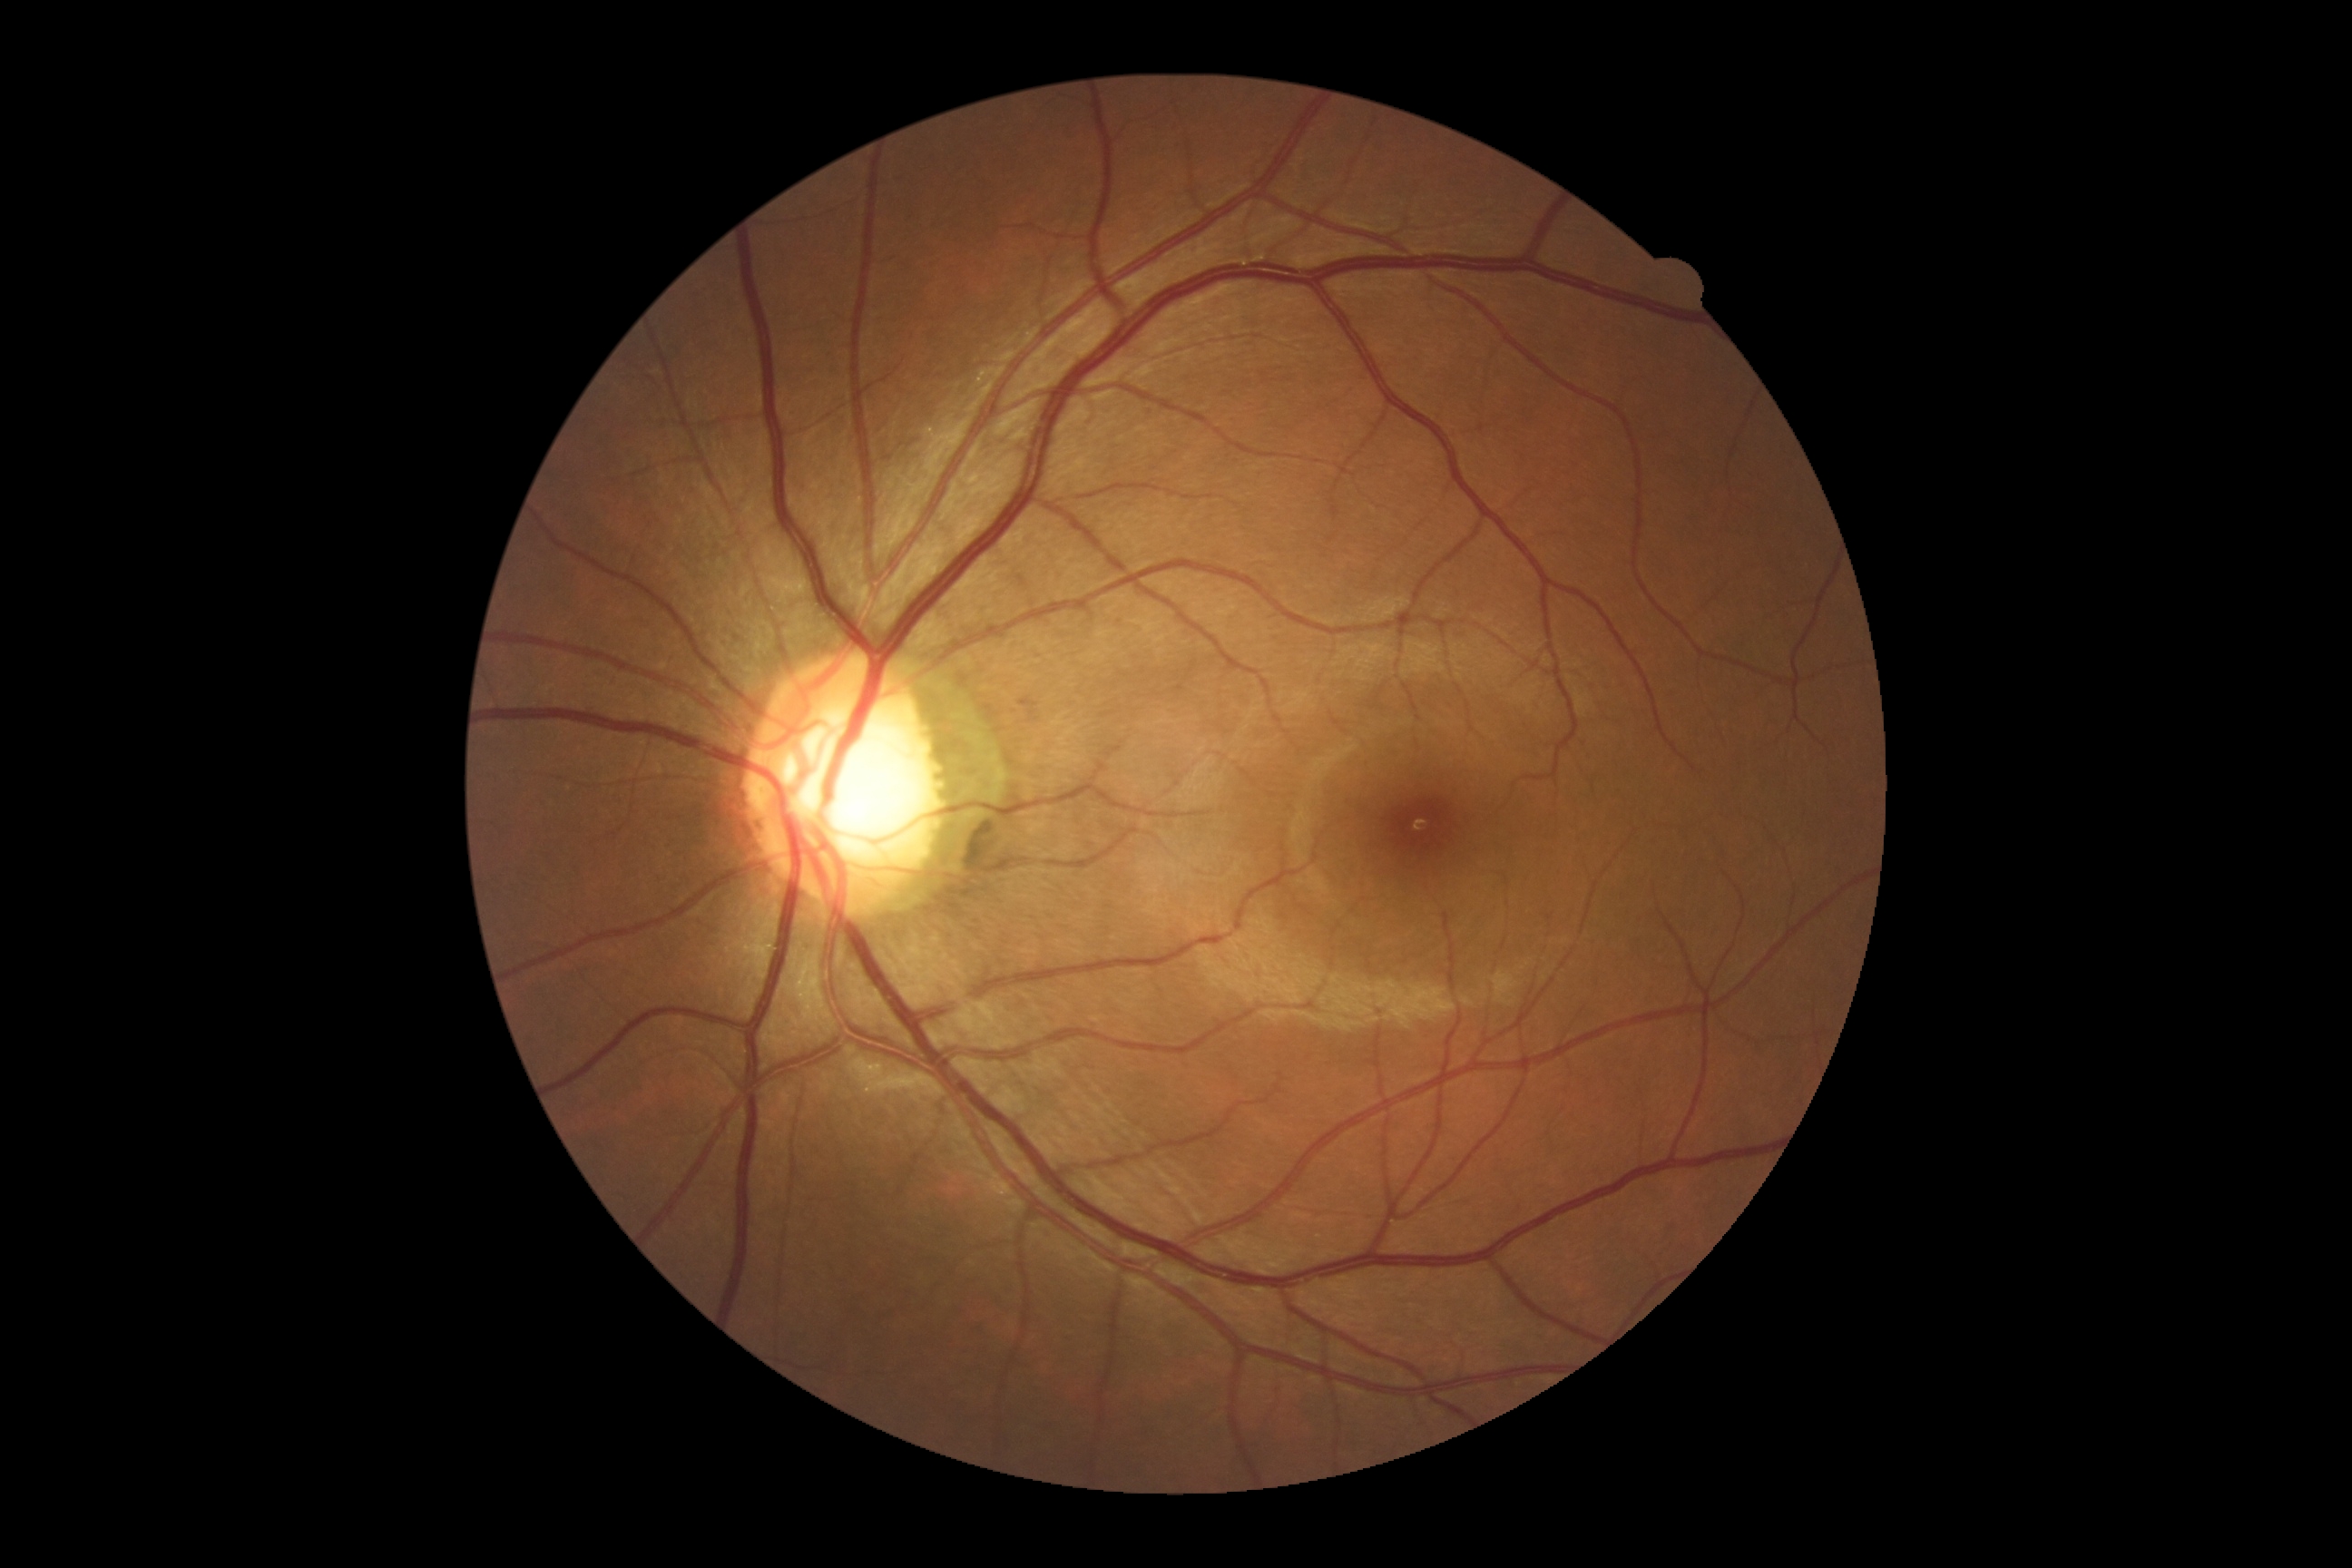 DR severity: 0/4.